2048x1536 — 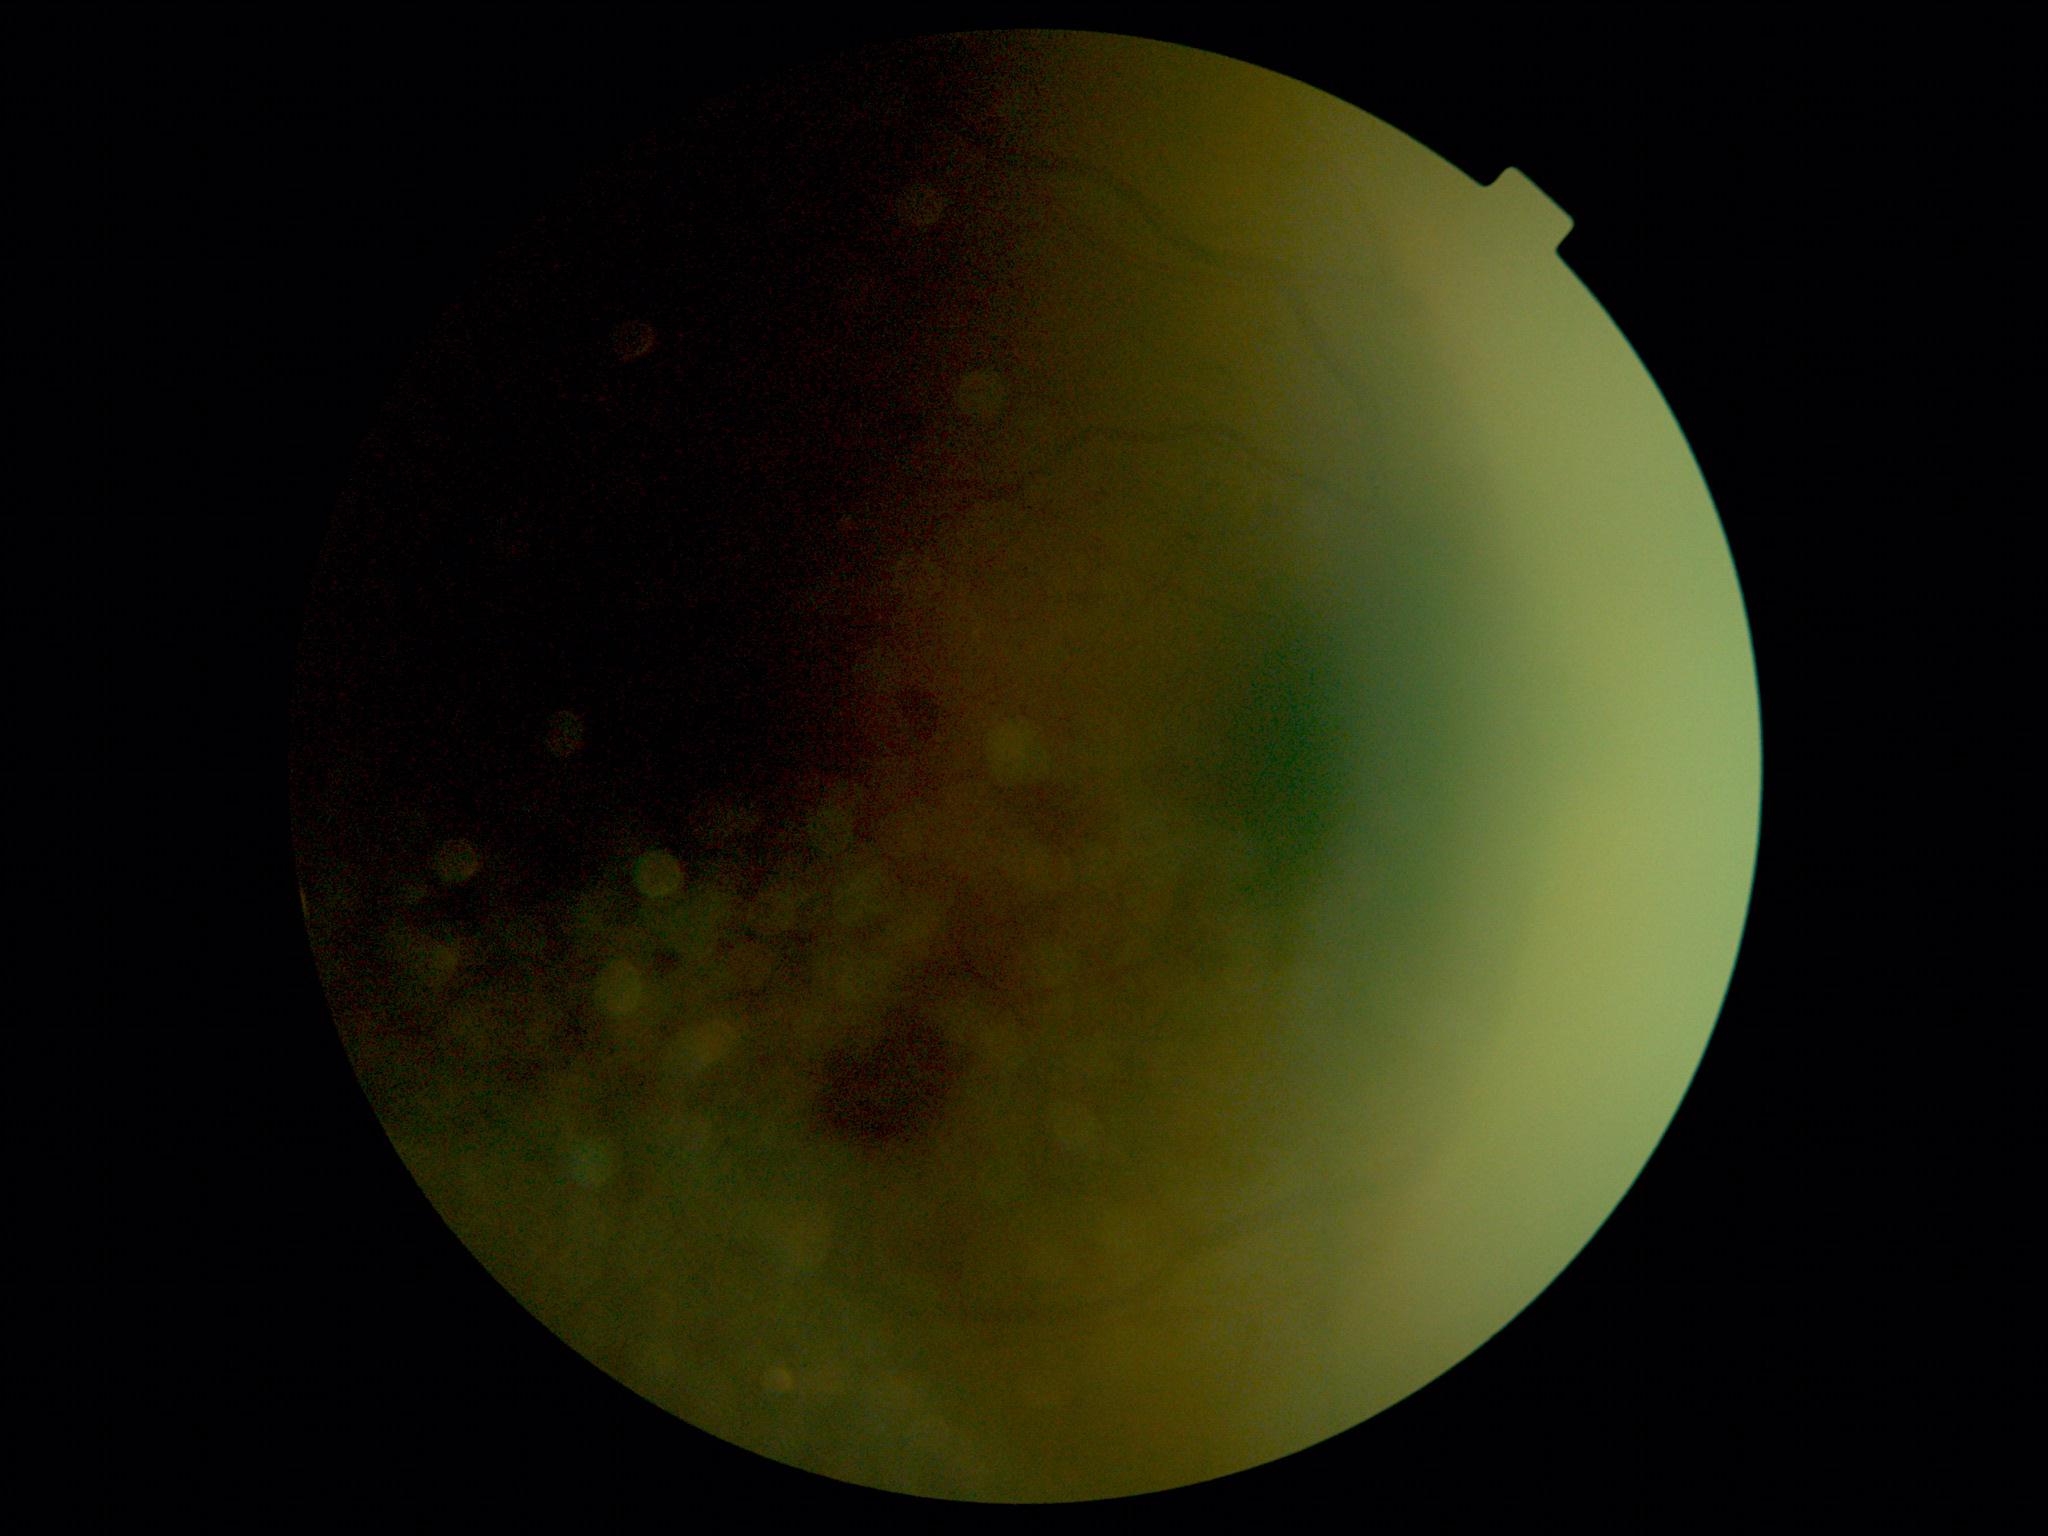
{
  "quality": "too poor for DR grading",
  "dr_grade": "ungradable"
}